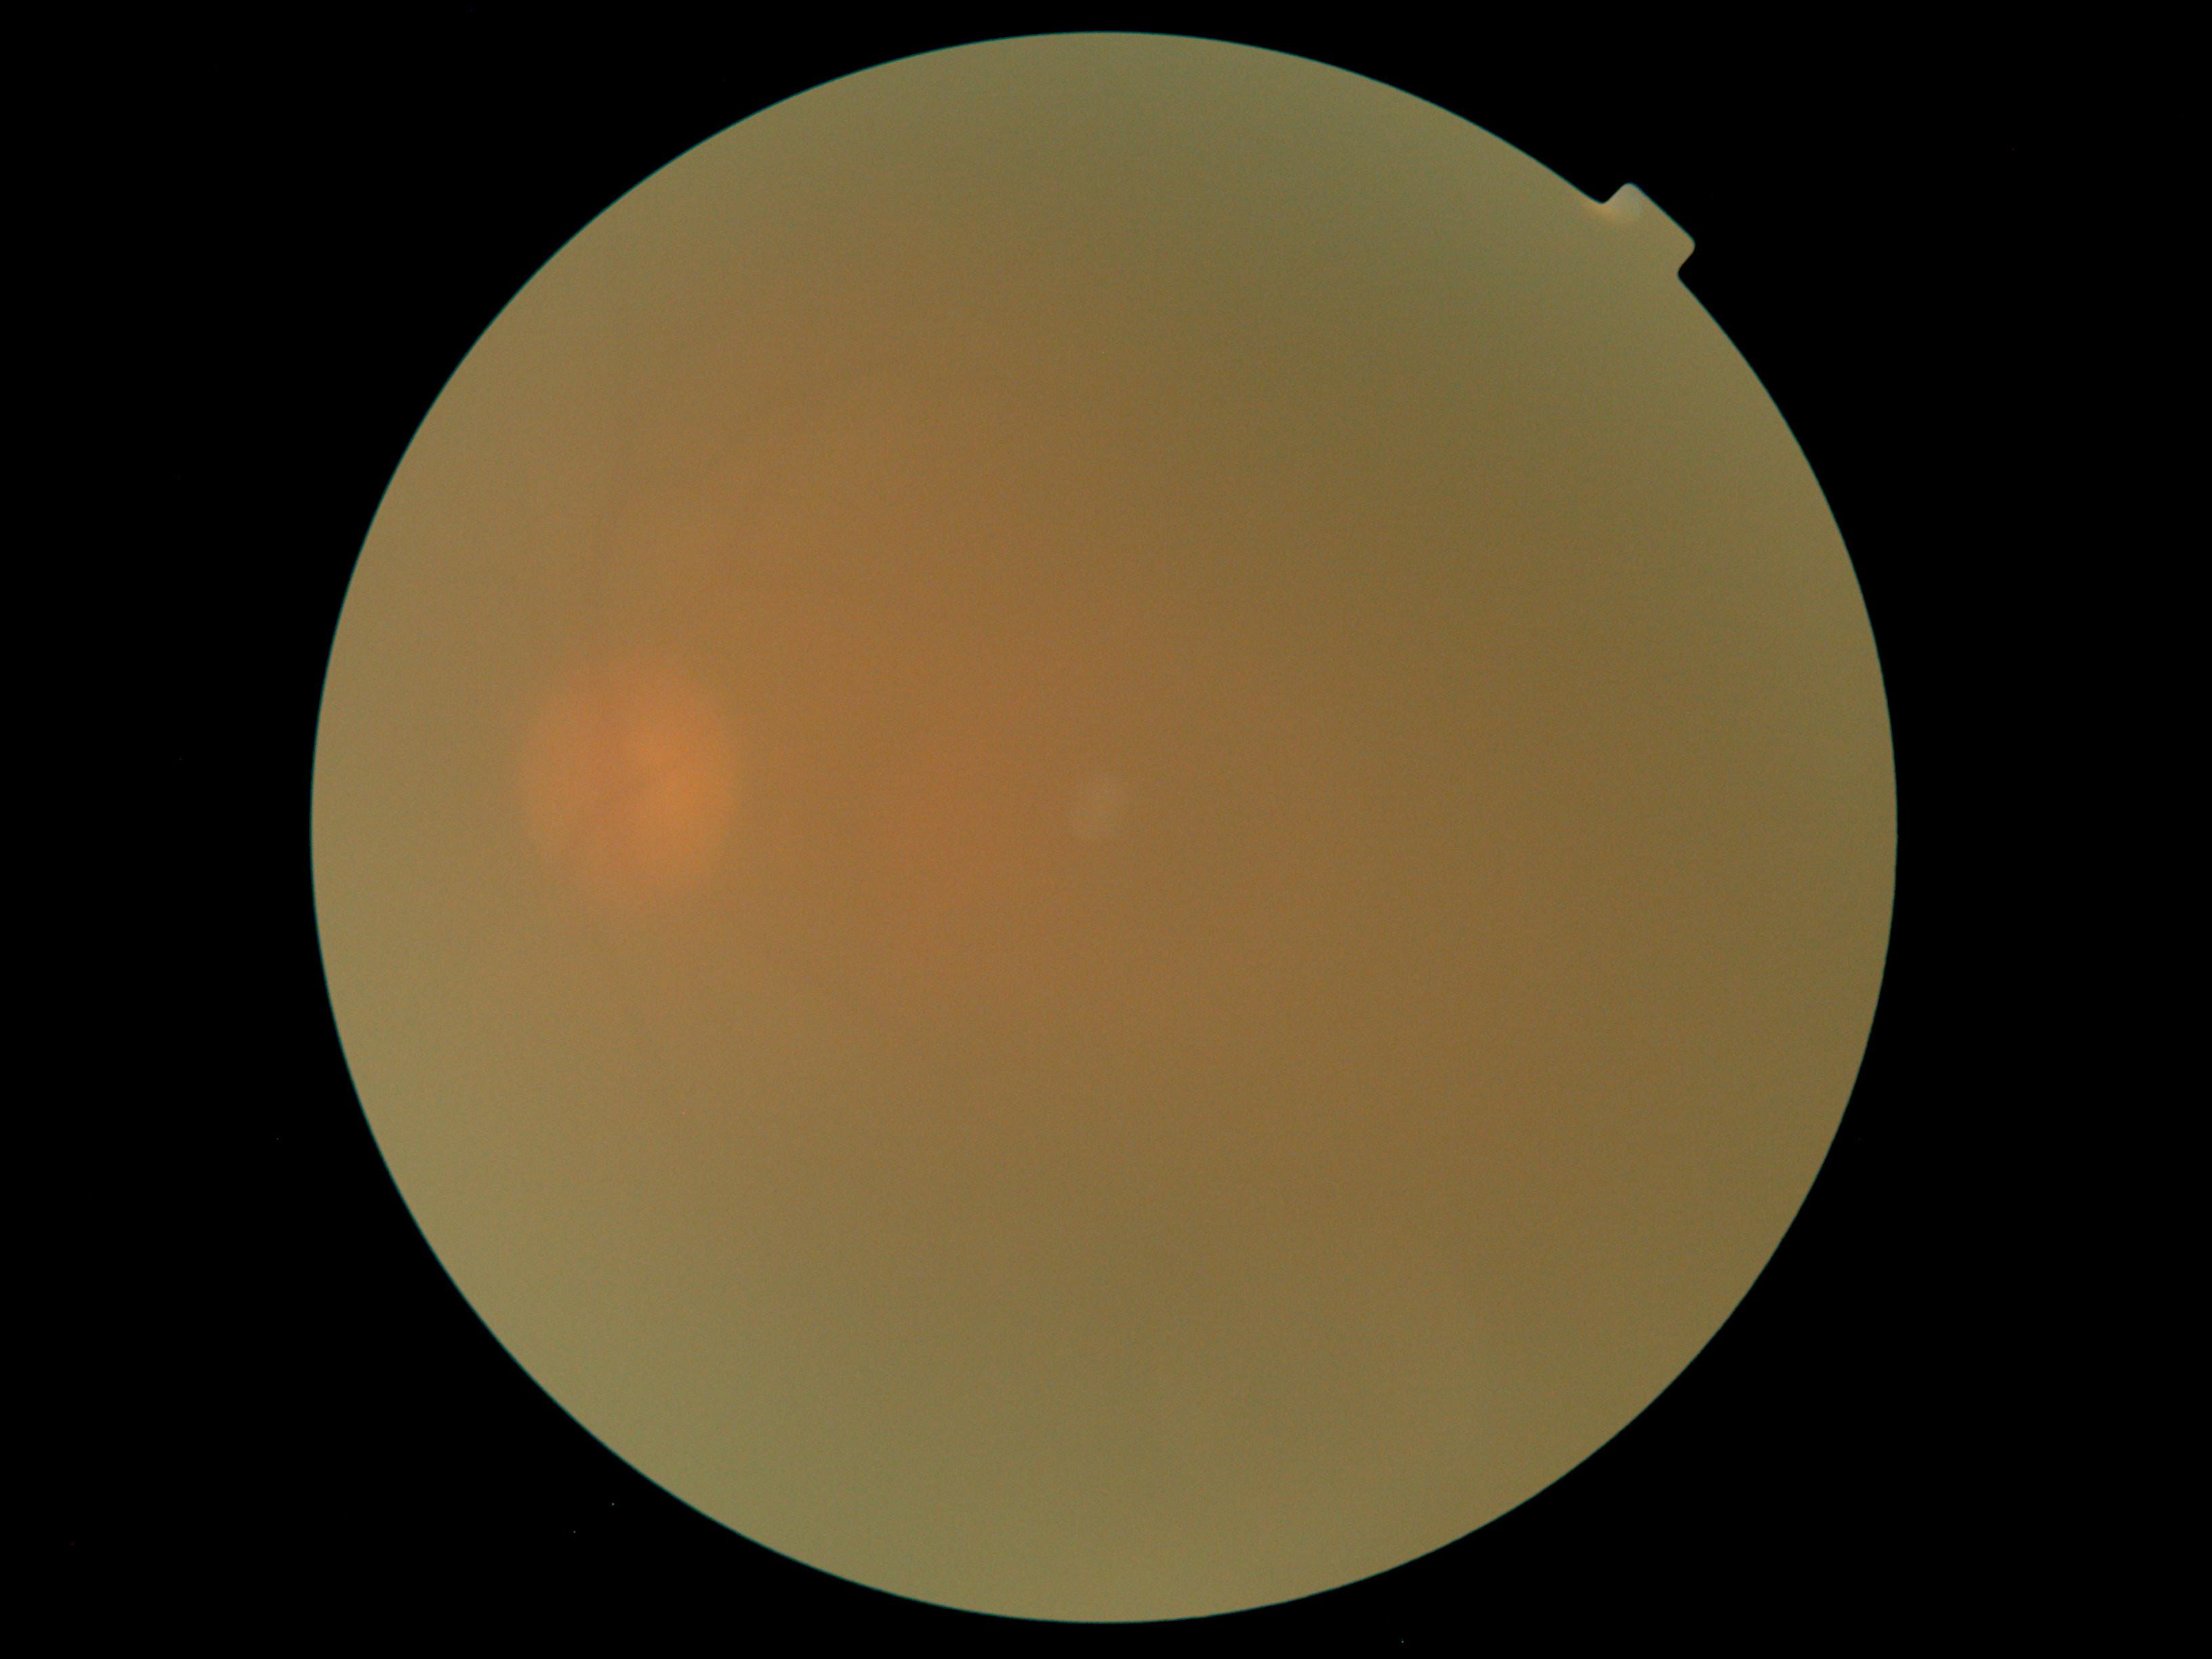 DR stage: ungradable due to poor image quality.